CFP.
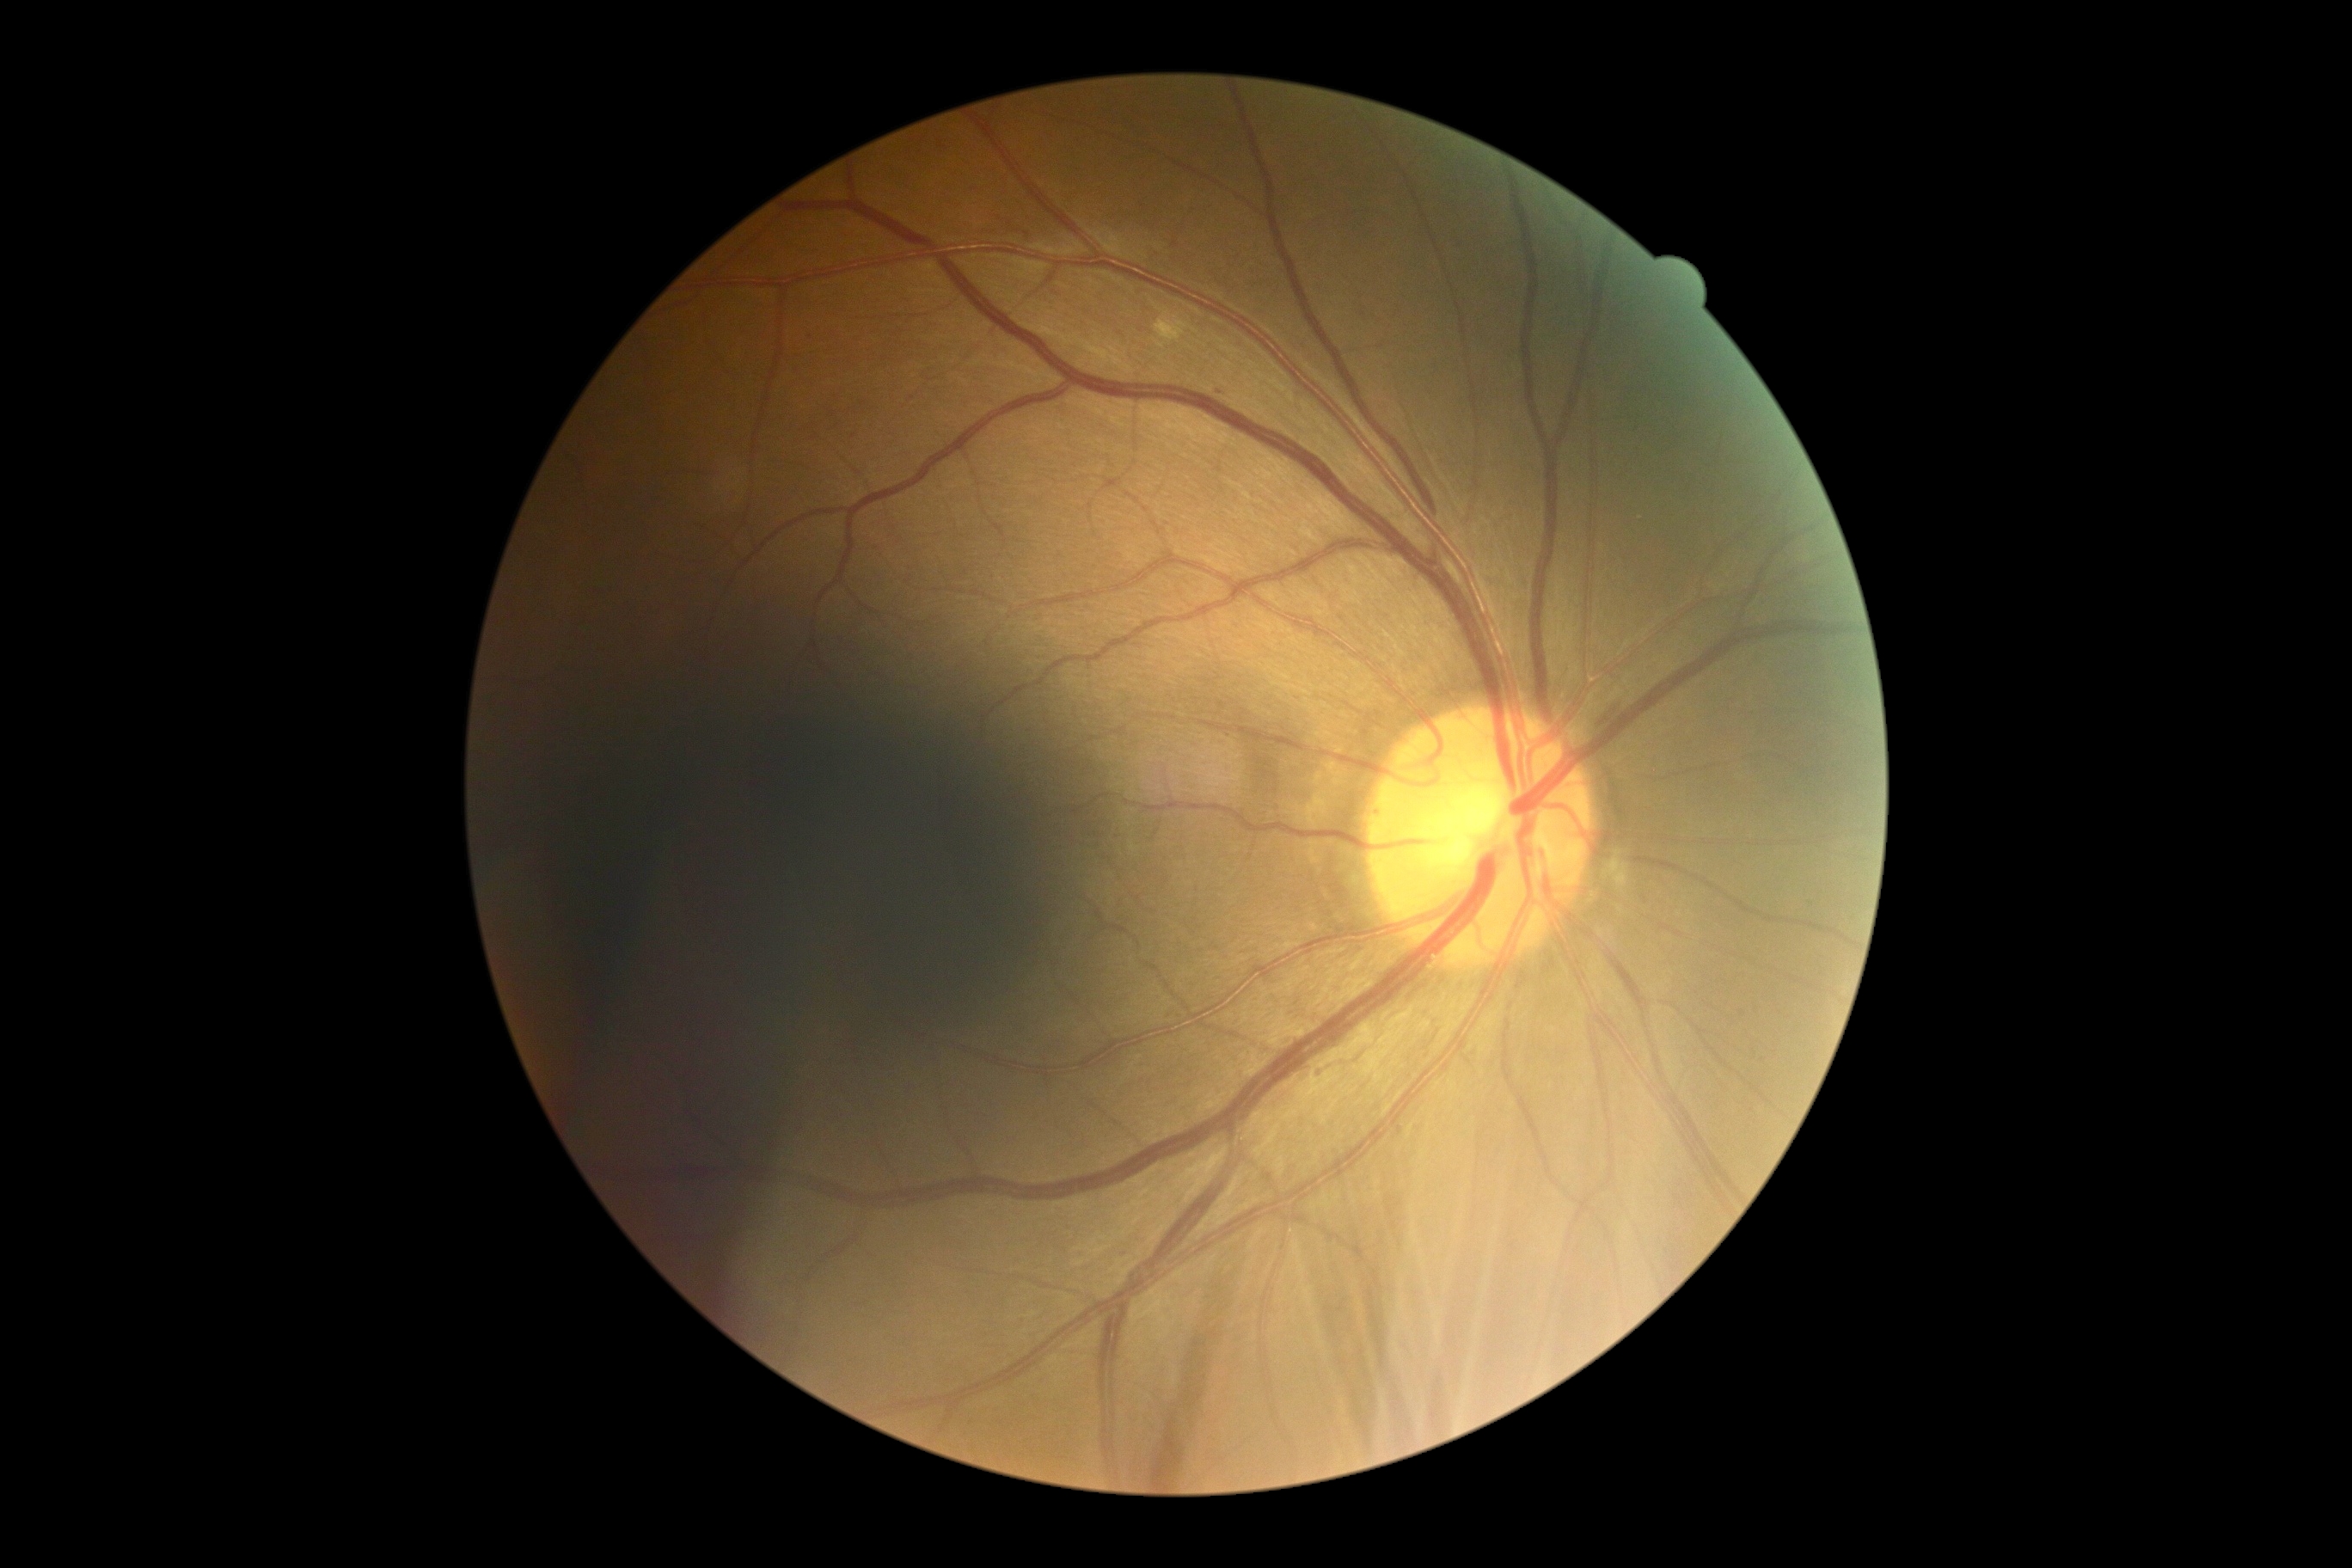

Findings:
– DR class — non-proliferative diabetic retinopathy
– diabetic retinopathy (DR) — grade 2